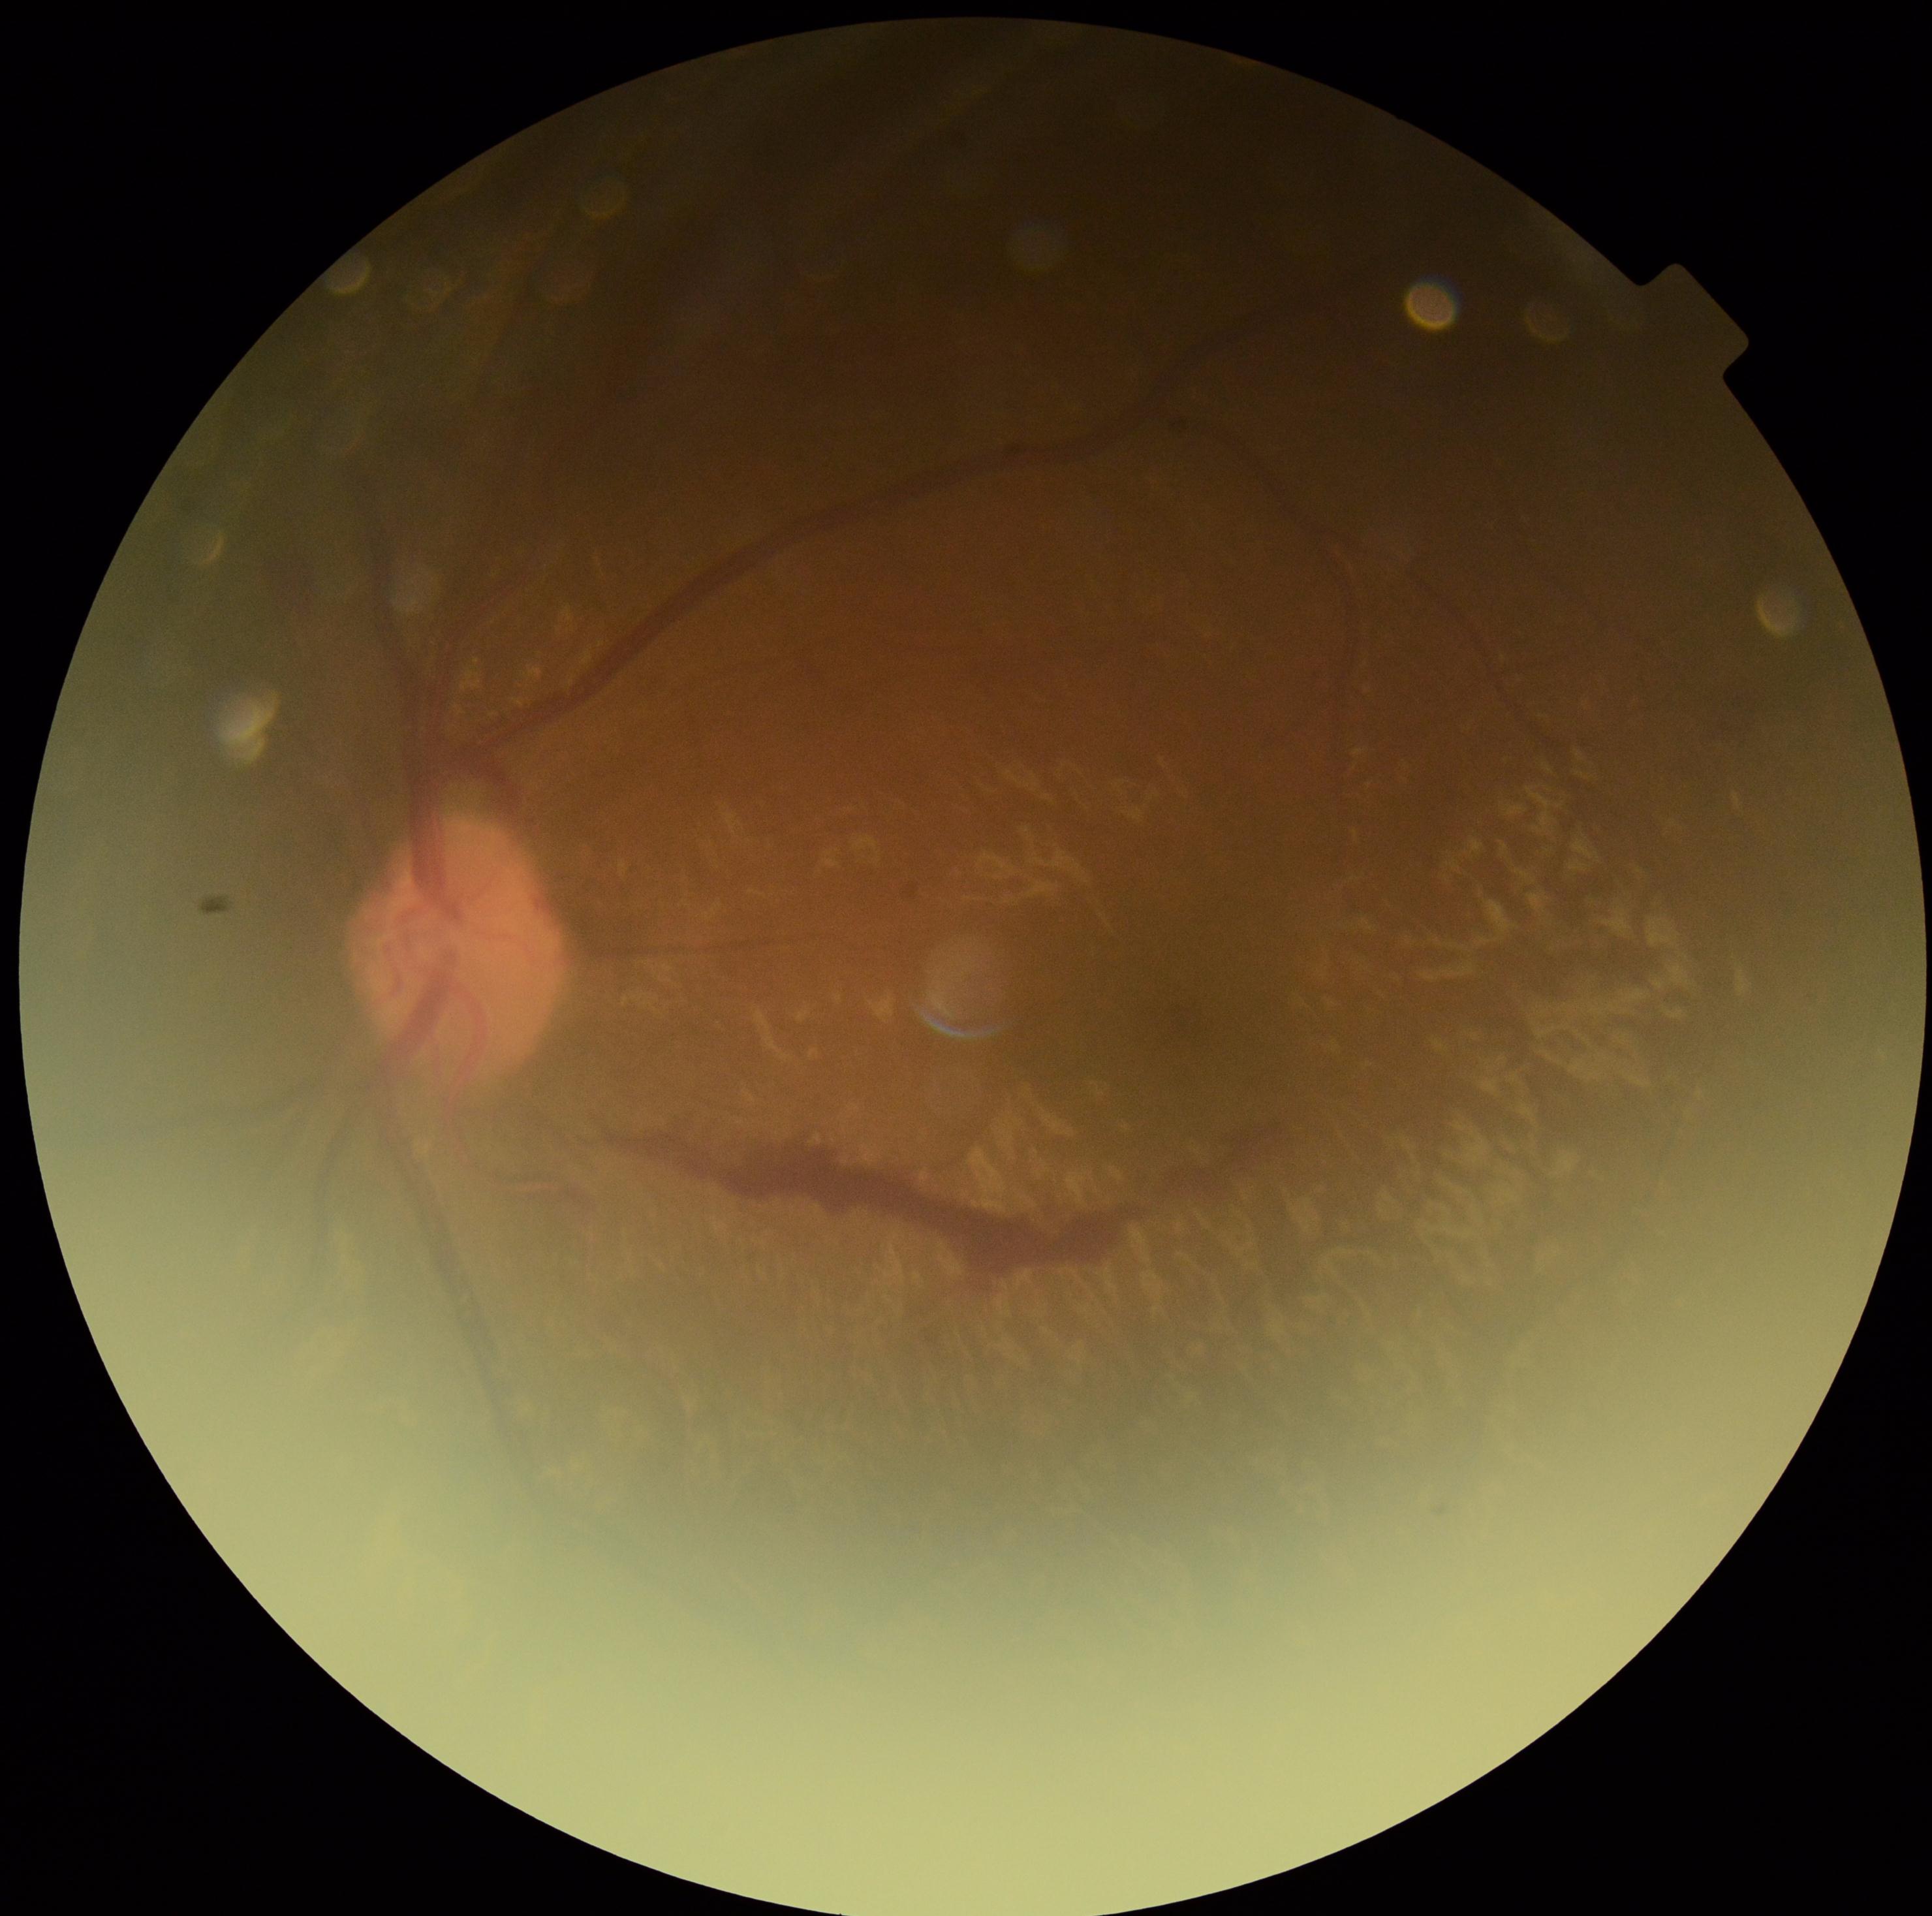

{
  "dr_grade": "PDR (4)"
}